Wide-field fundus image from infant ROP screening — 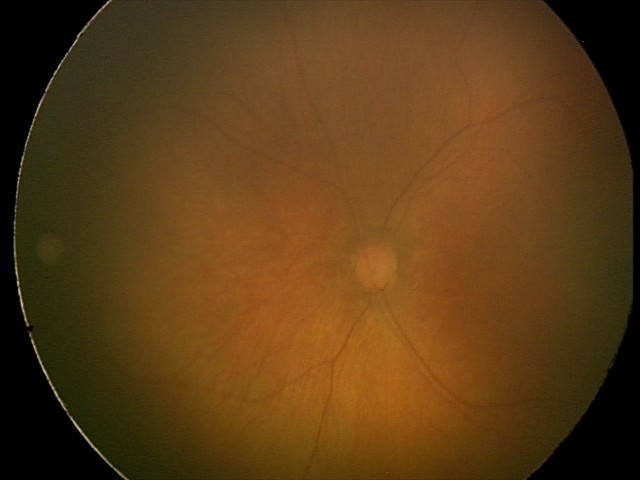 Screening examination diagnosed as physiological.